45° field of view.
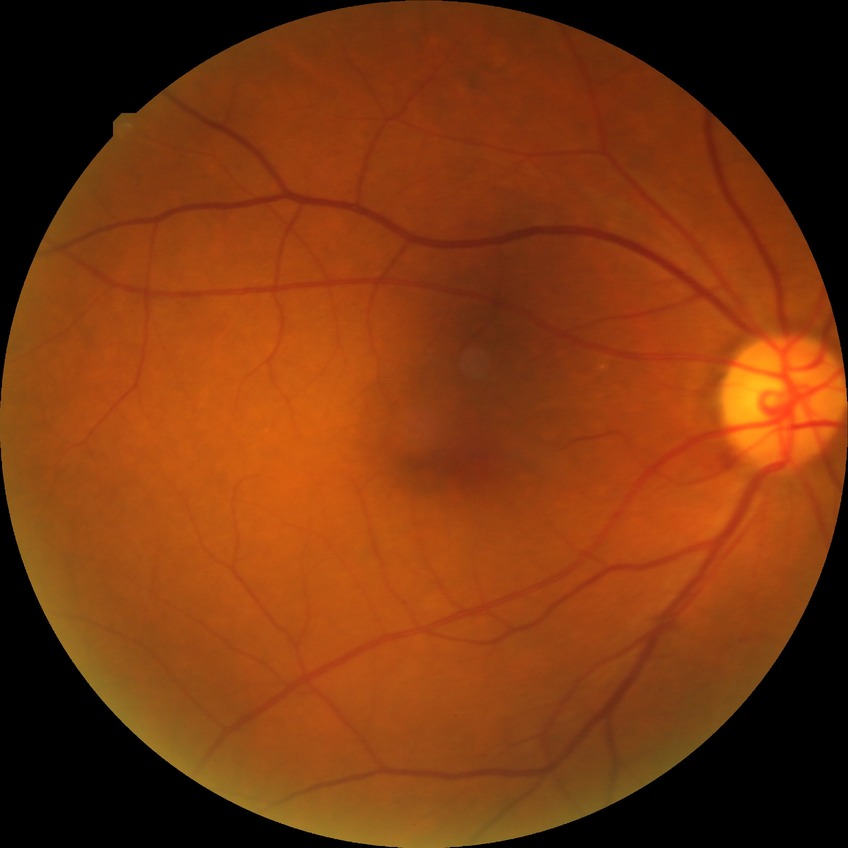
Annotations:
- diabetic retinopathy (DR): SDR (simple diabetic retinopathy)